Optic disc-centered · camera: Topcon TRC-NW400 — 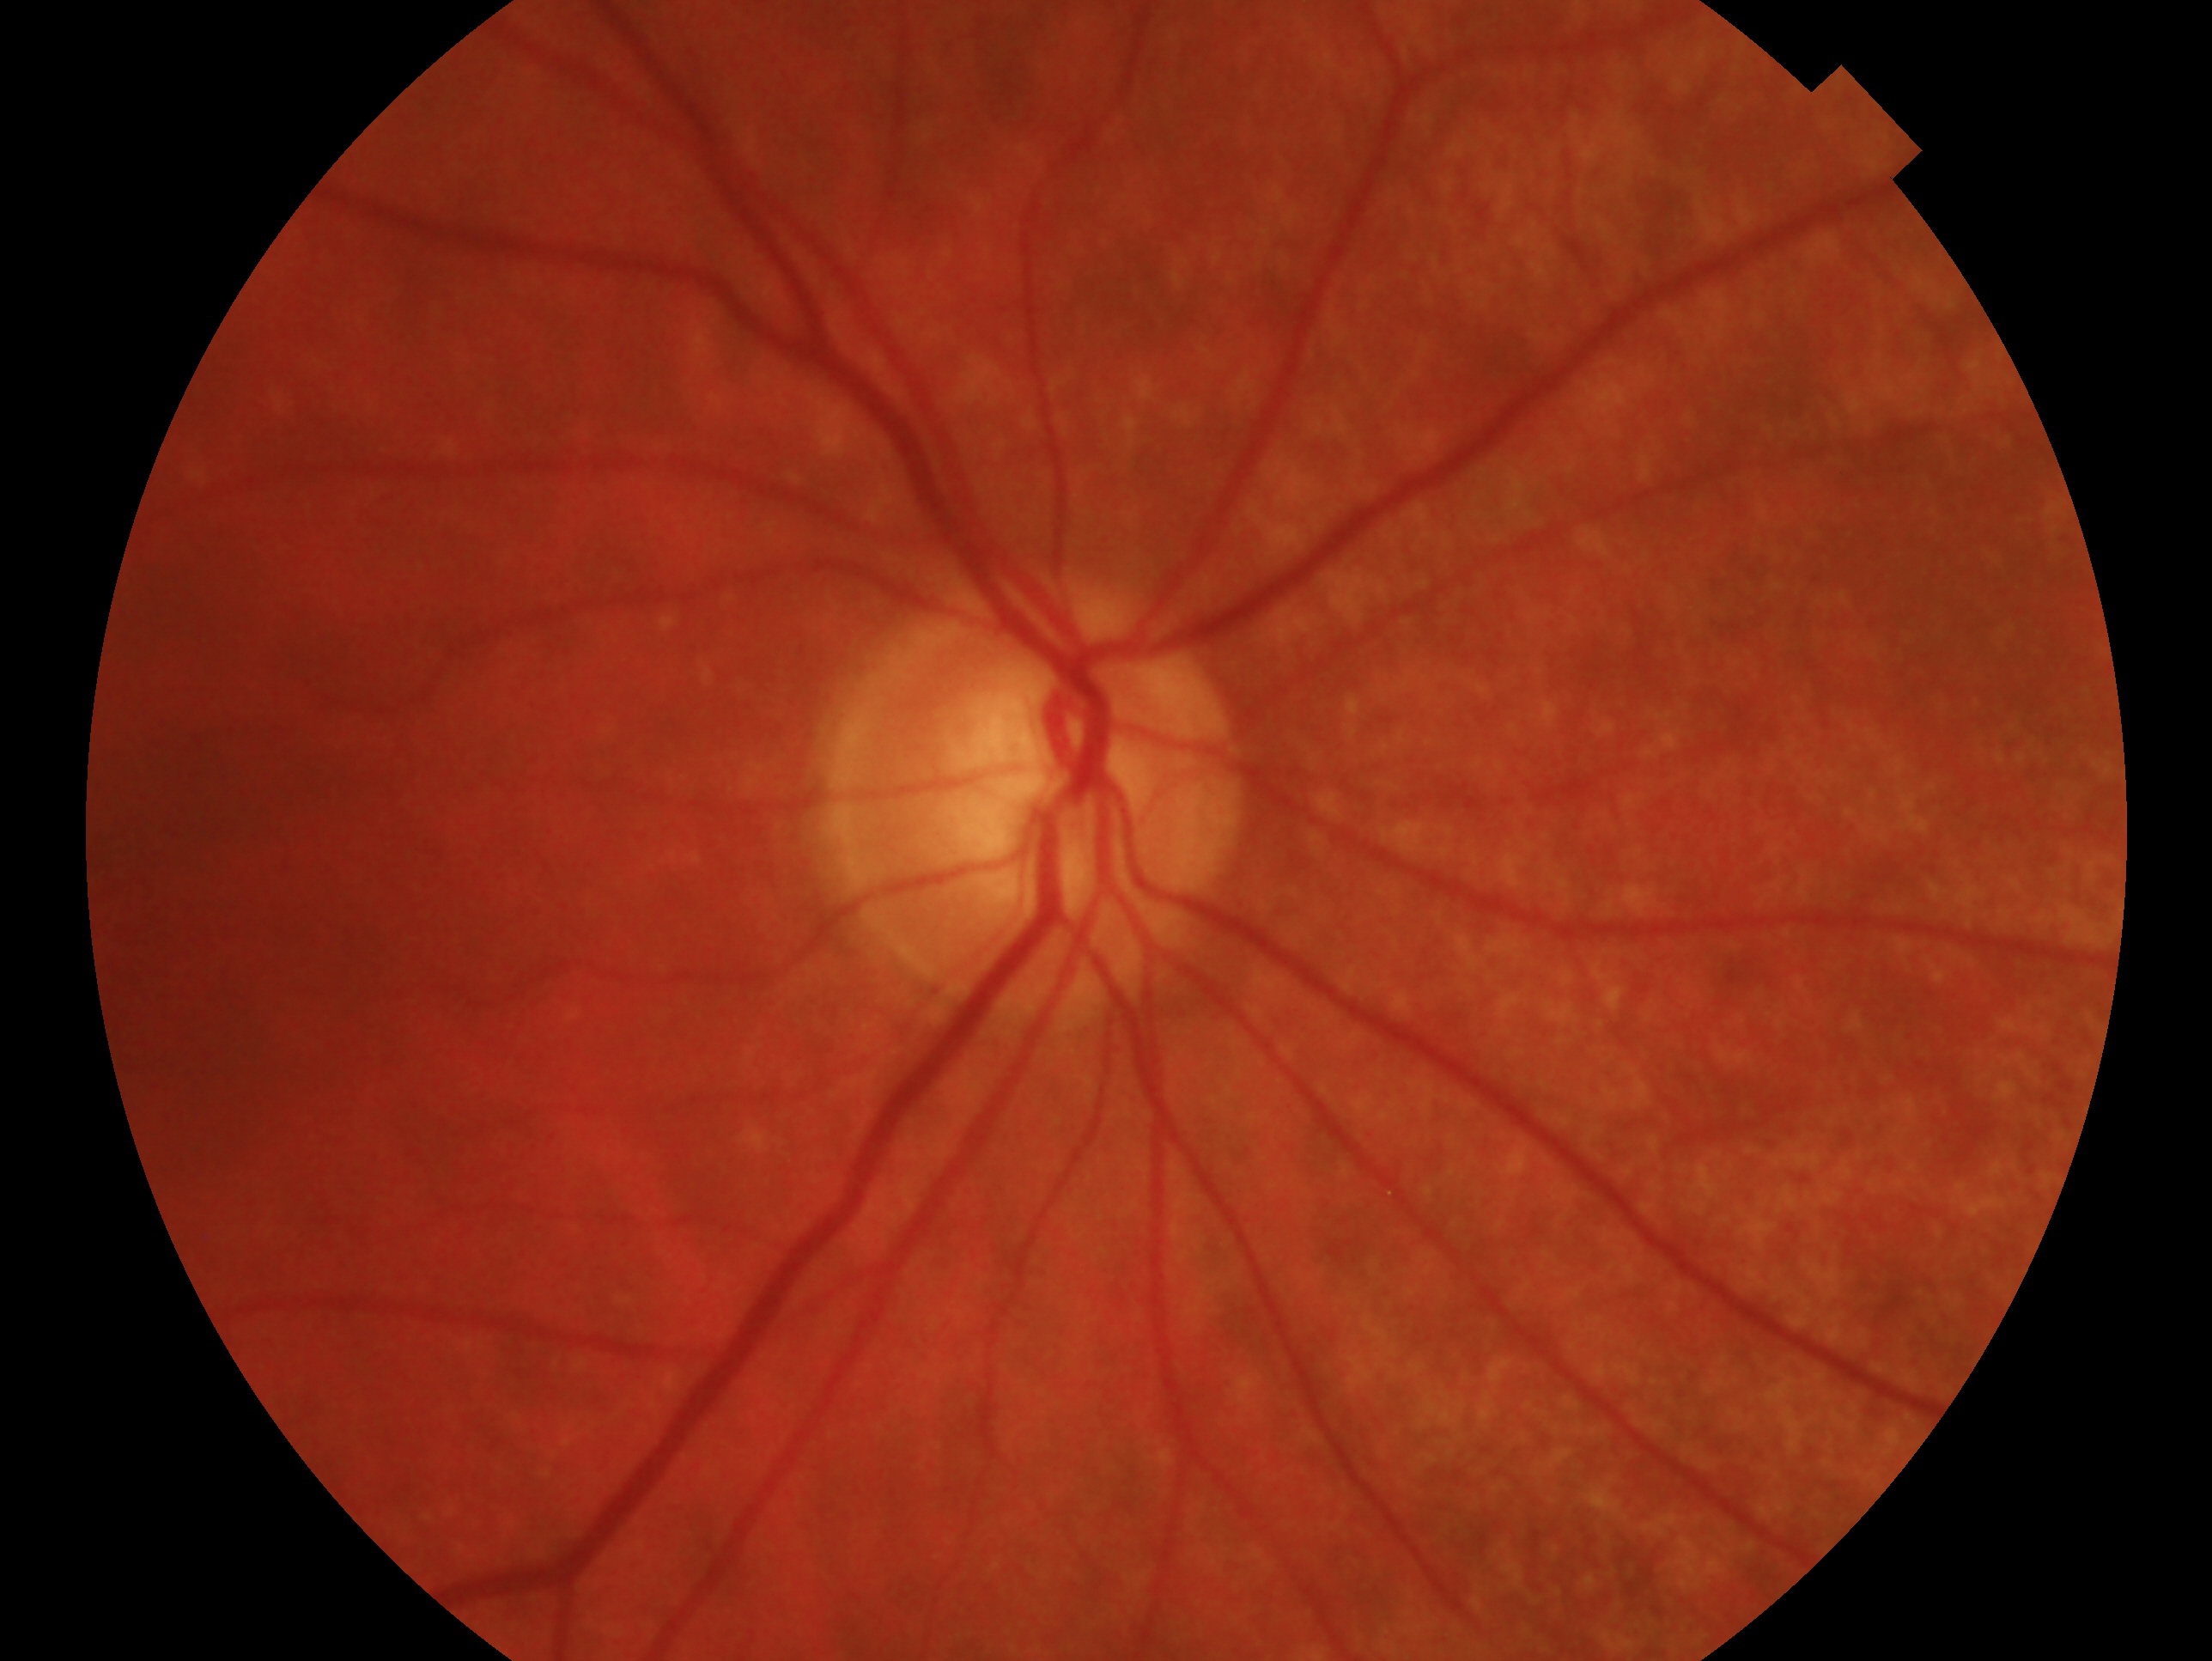 - laterality — right eye
- glaucoma status — consistent with glaucoma